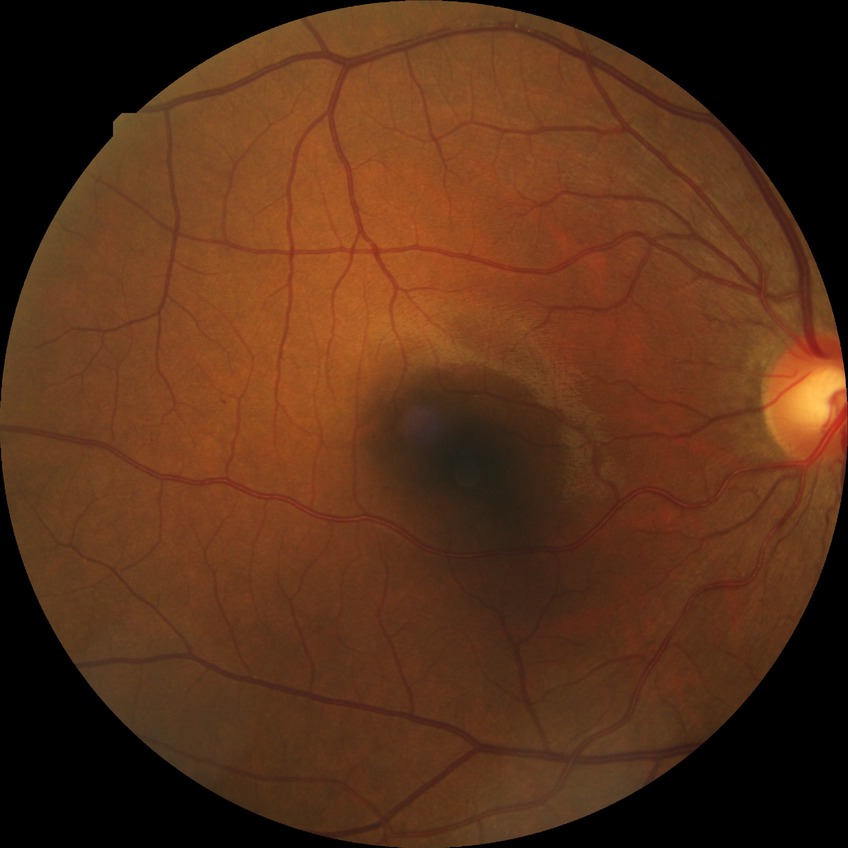

Davis grading@simple diabetic retinopathy.